Nonmydriatic; 45° FOV.
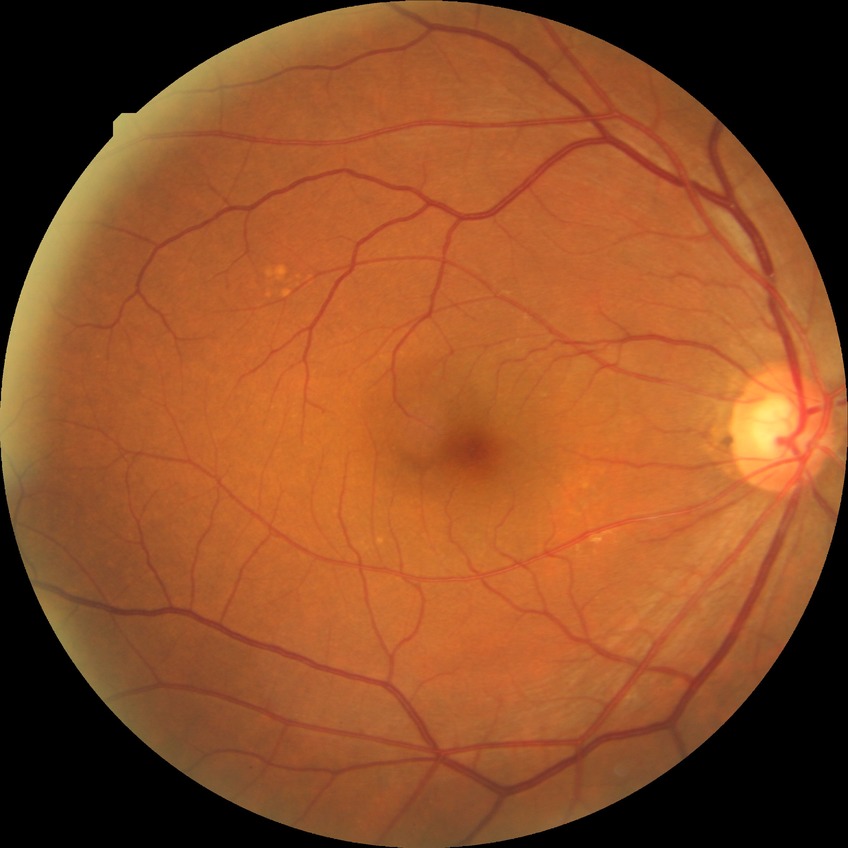 diabetic retinopathy (DR) = no diabetic retinopathy (NDR)